FOV: 45 degrees, 1960x1897
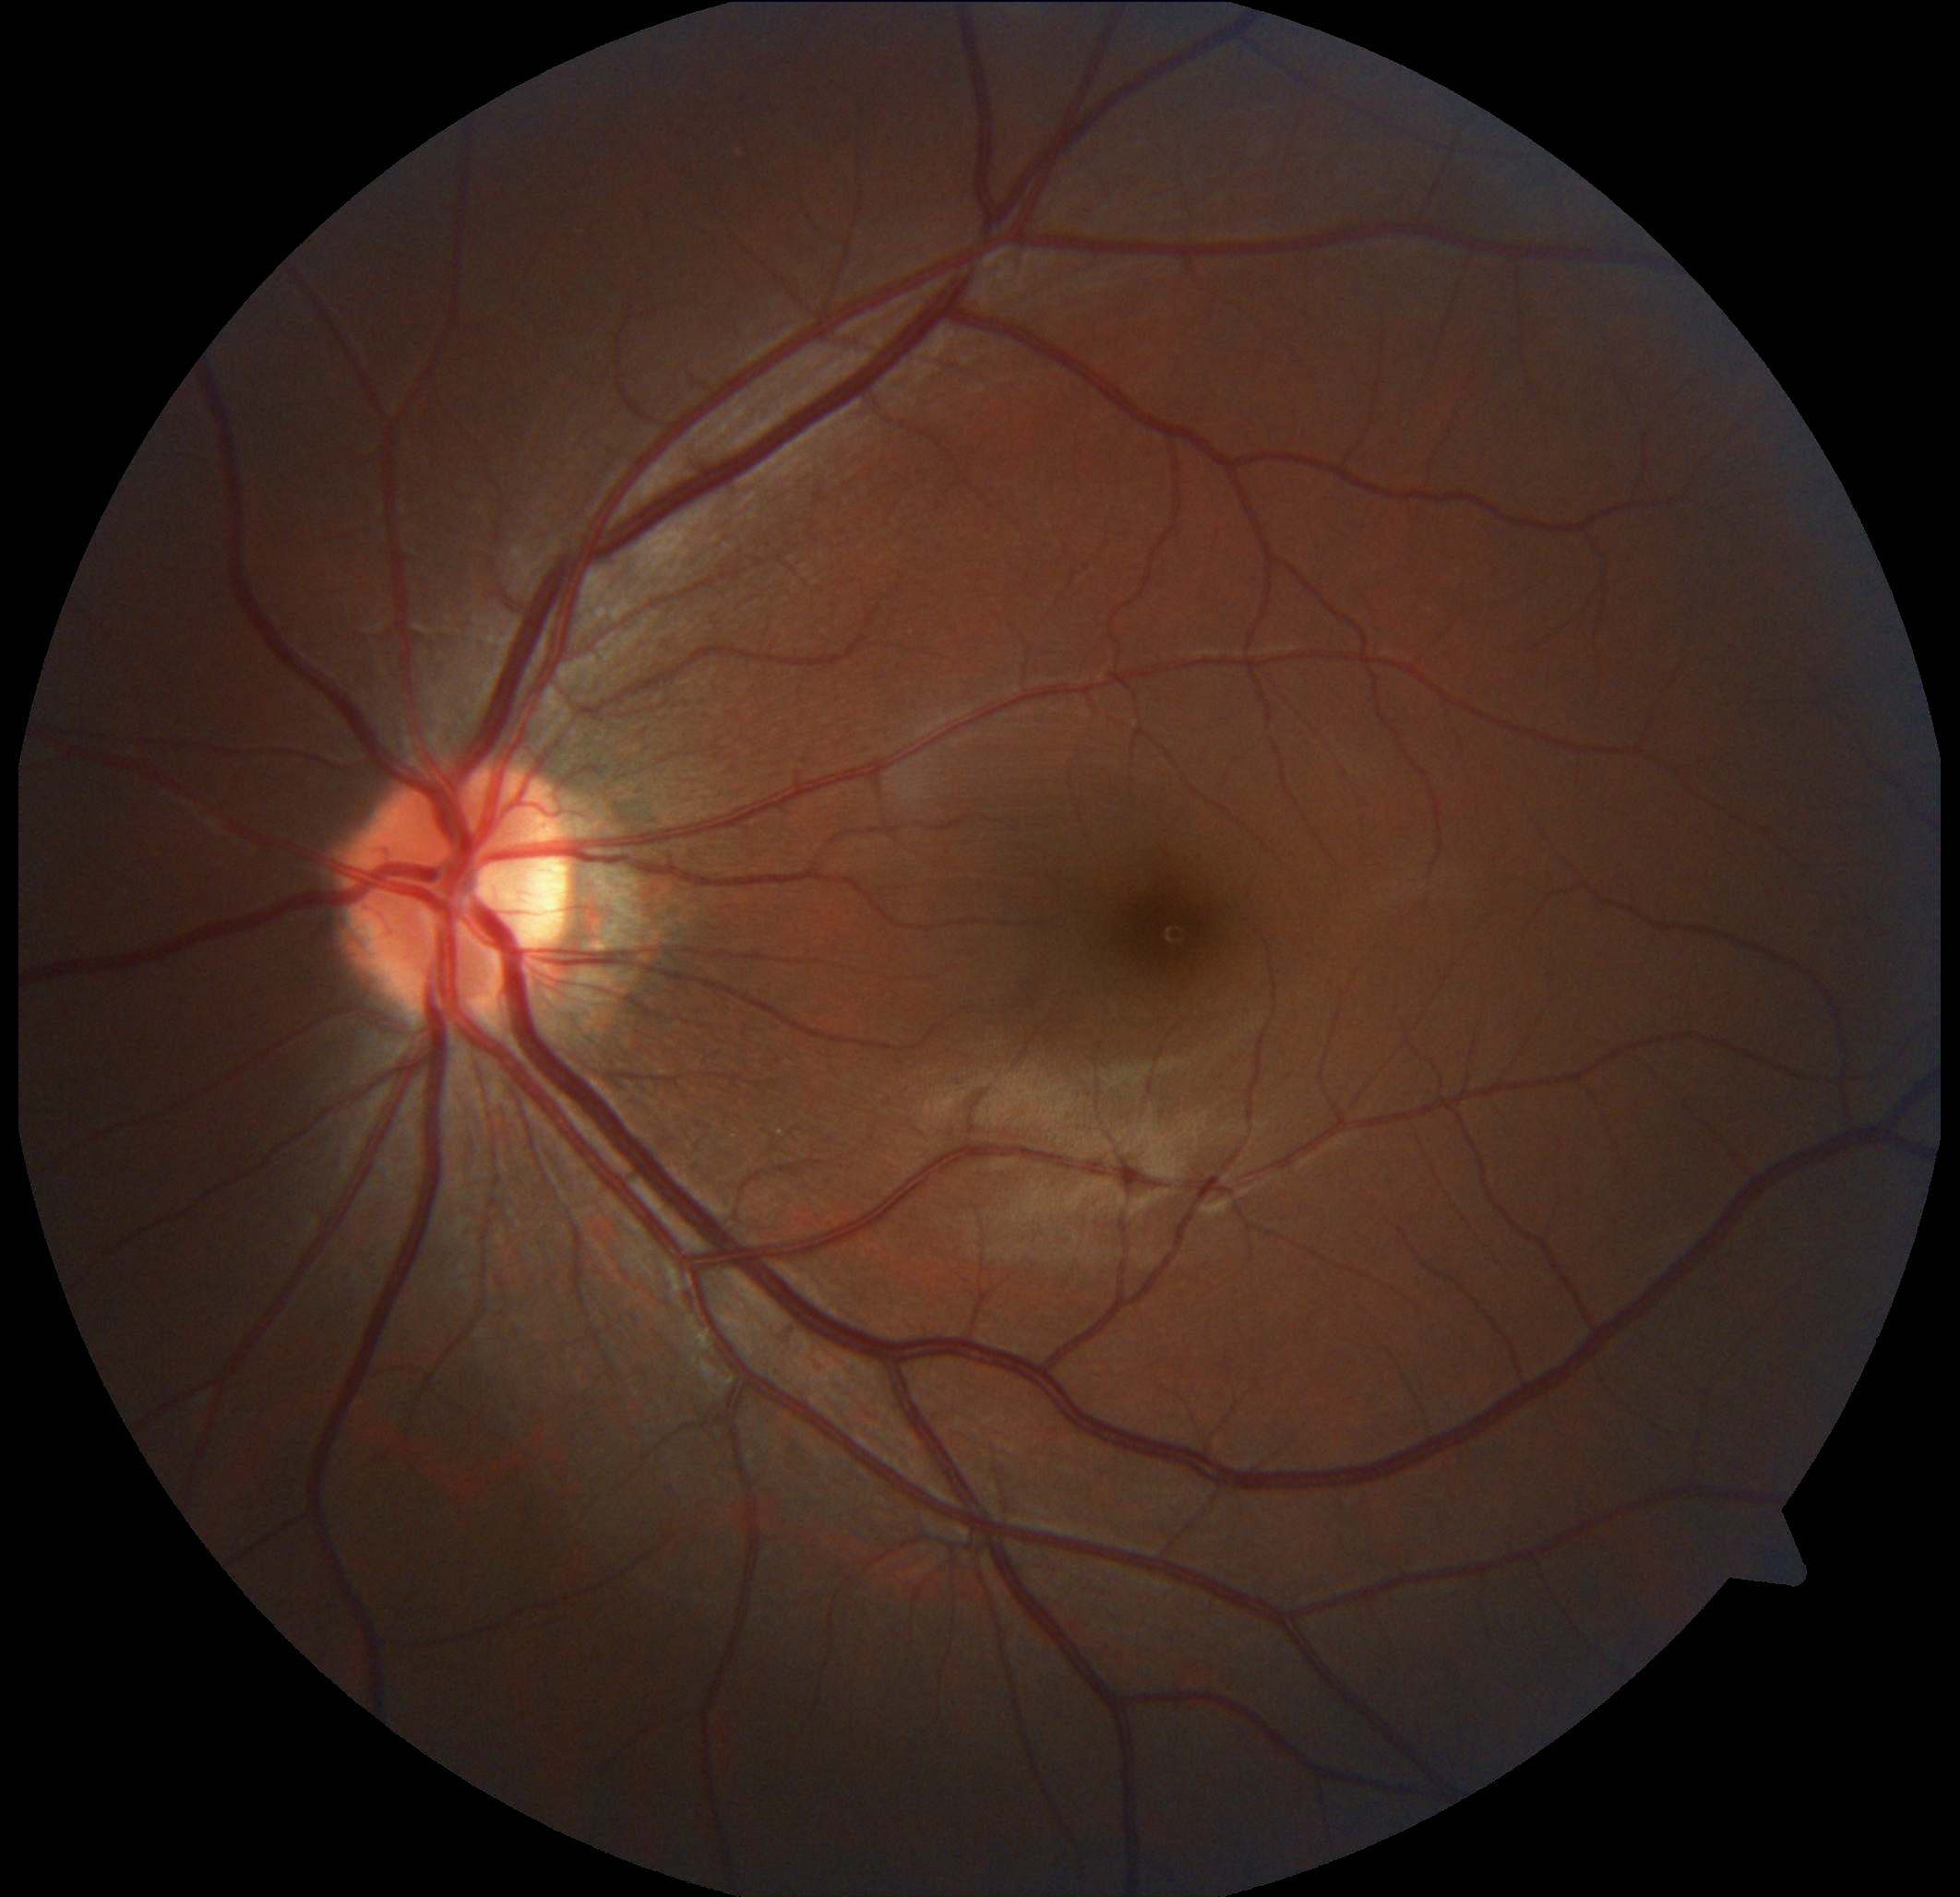

DR impression: no apparent DR, diabetic retinopathy (DR): no apparent retinopathy (grade 0).